Wide-field fundus image from infant ROP screening · 1240x1240px:
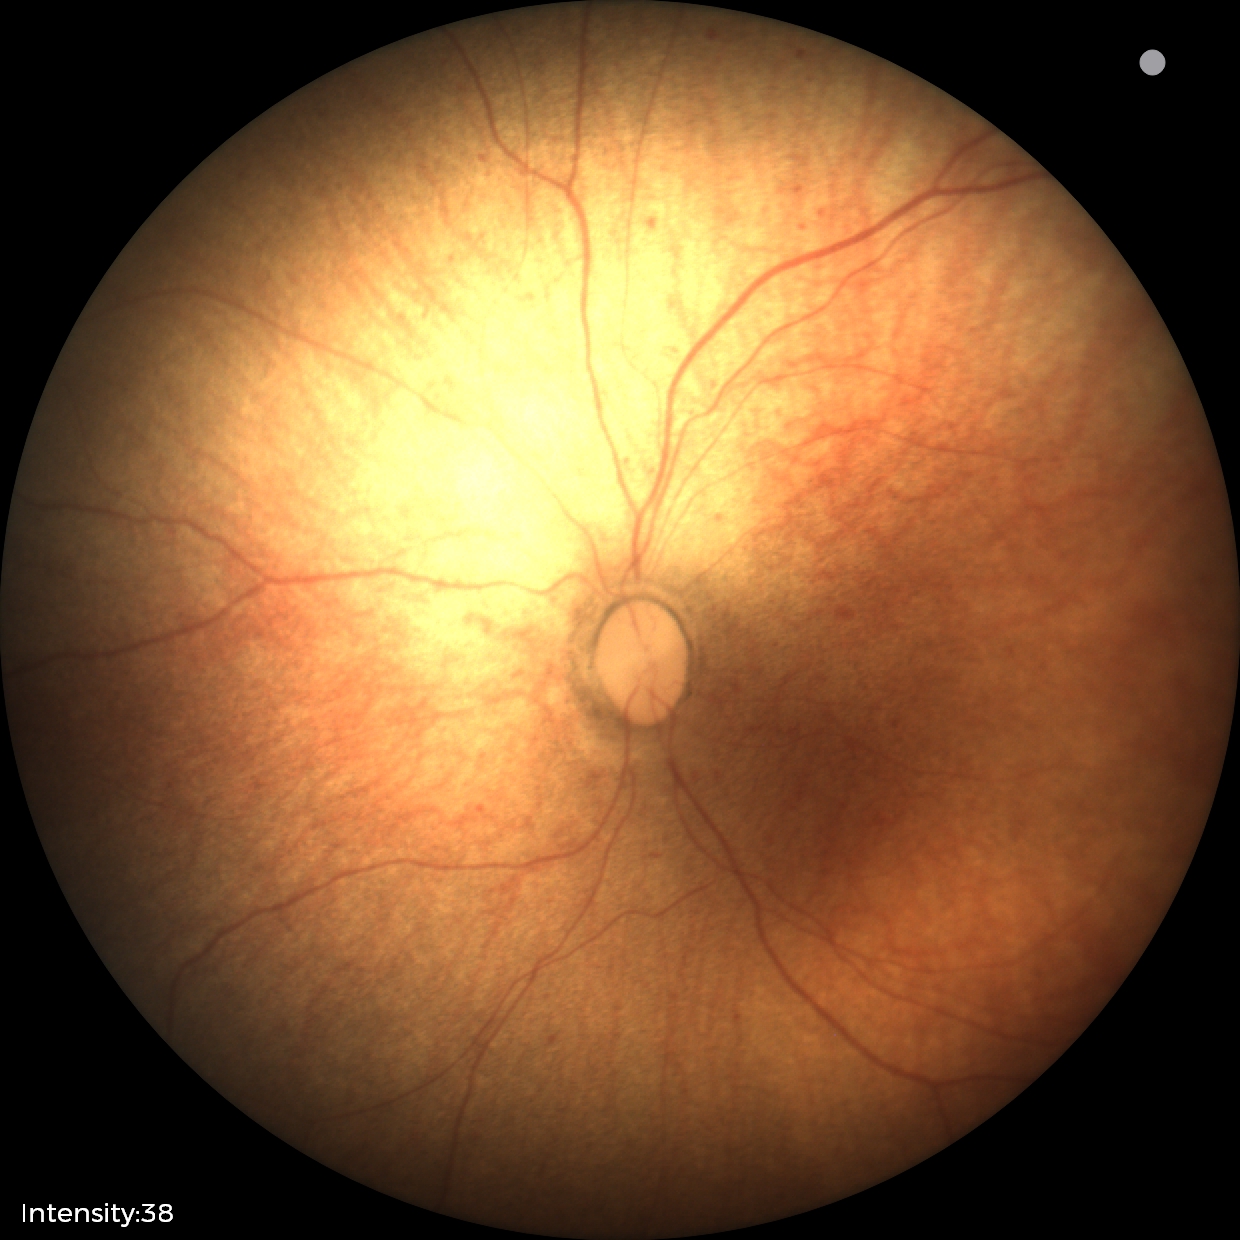 Impression: no abnormal retinal findings.